Wide-field fundus photograph of an infant; 130° field of view (Natus RetCam Envision); 1440x1080px — 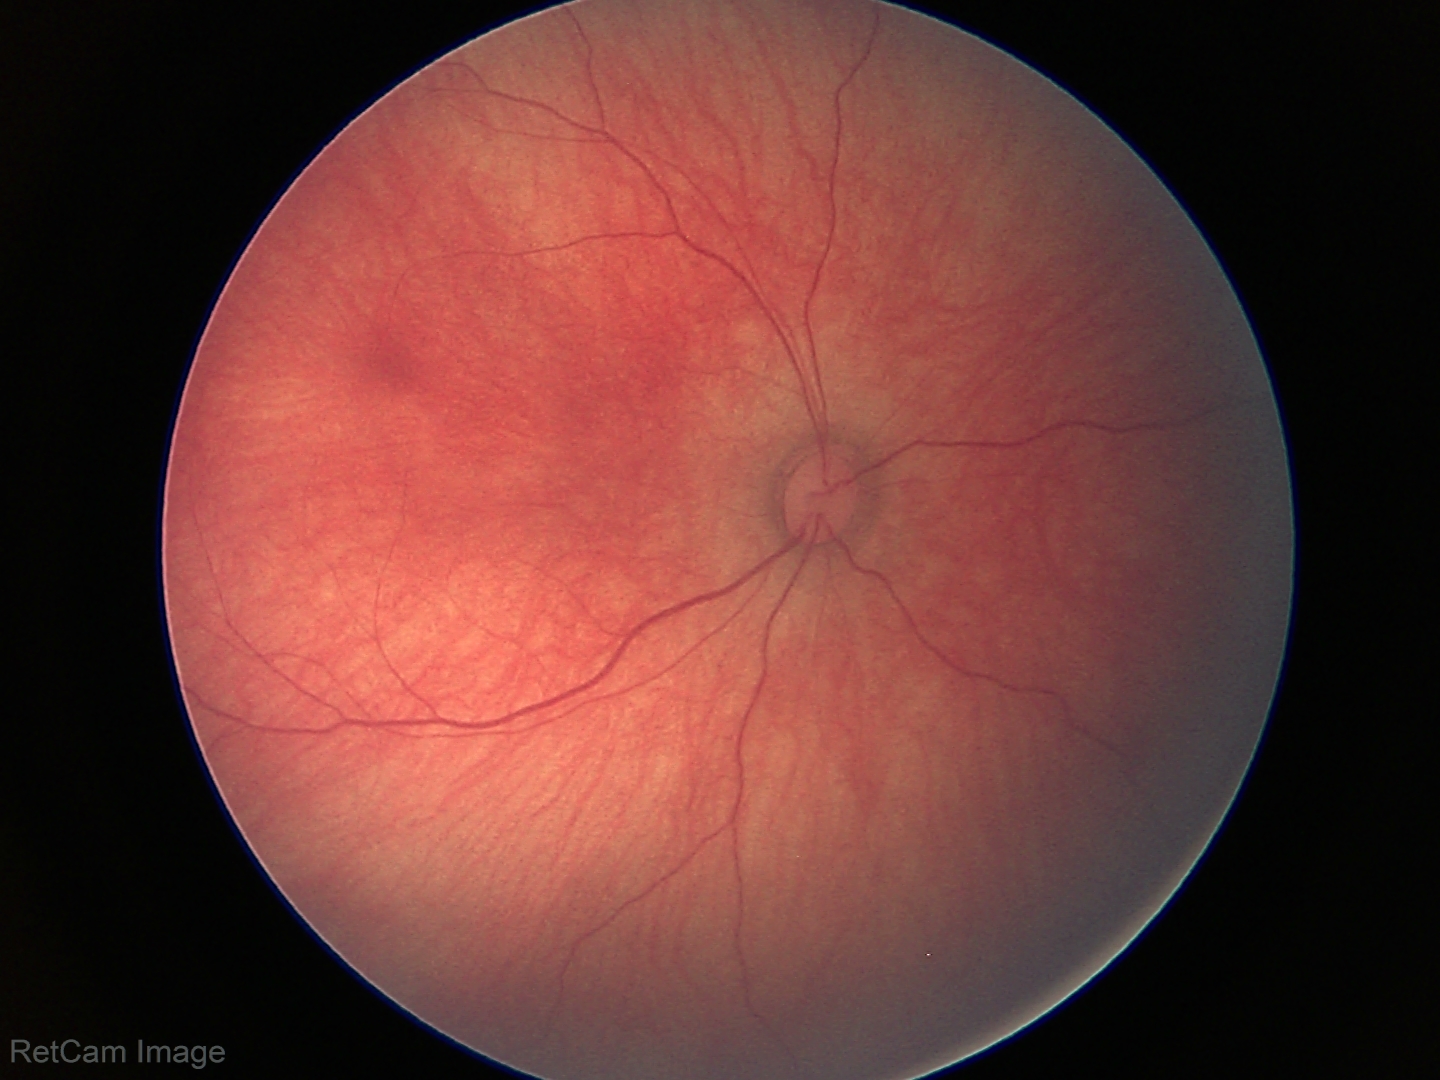

Screening examination with no abnormal retinal findings.